45° field of view, image size 2352x1568, fundus photo — 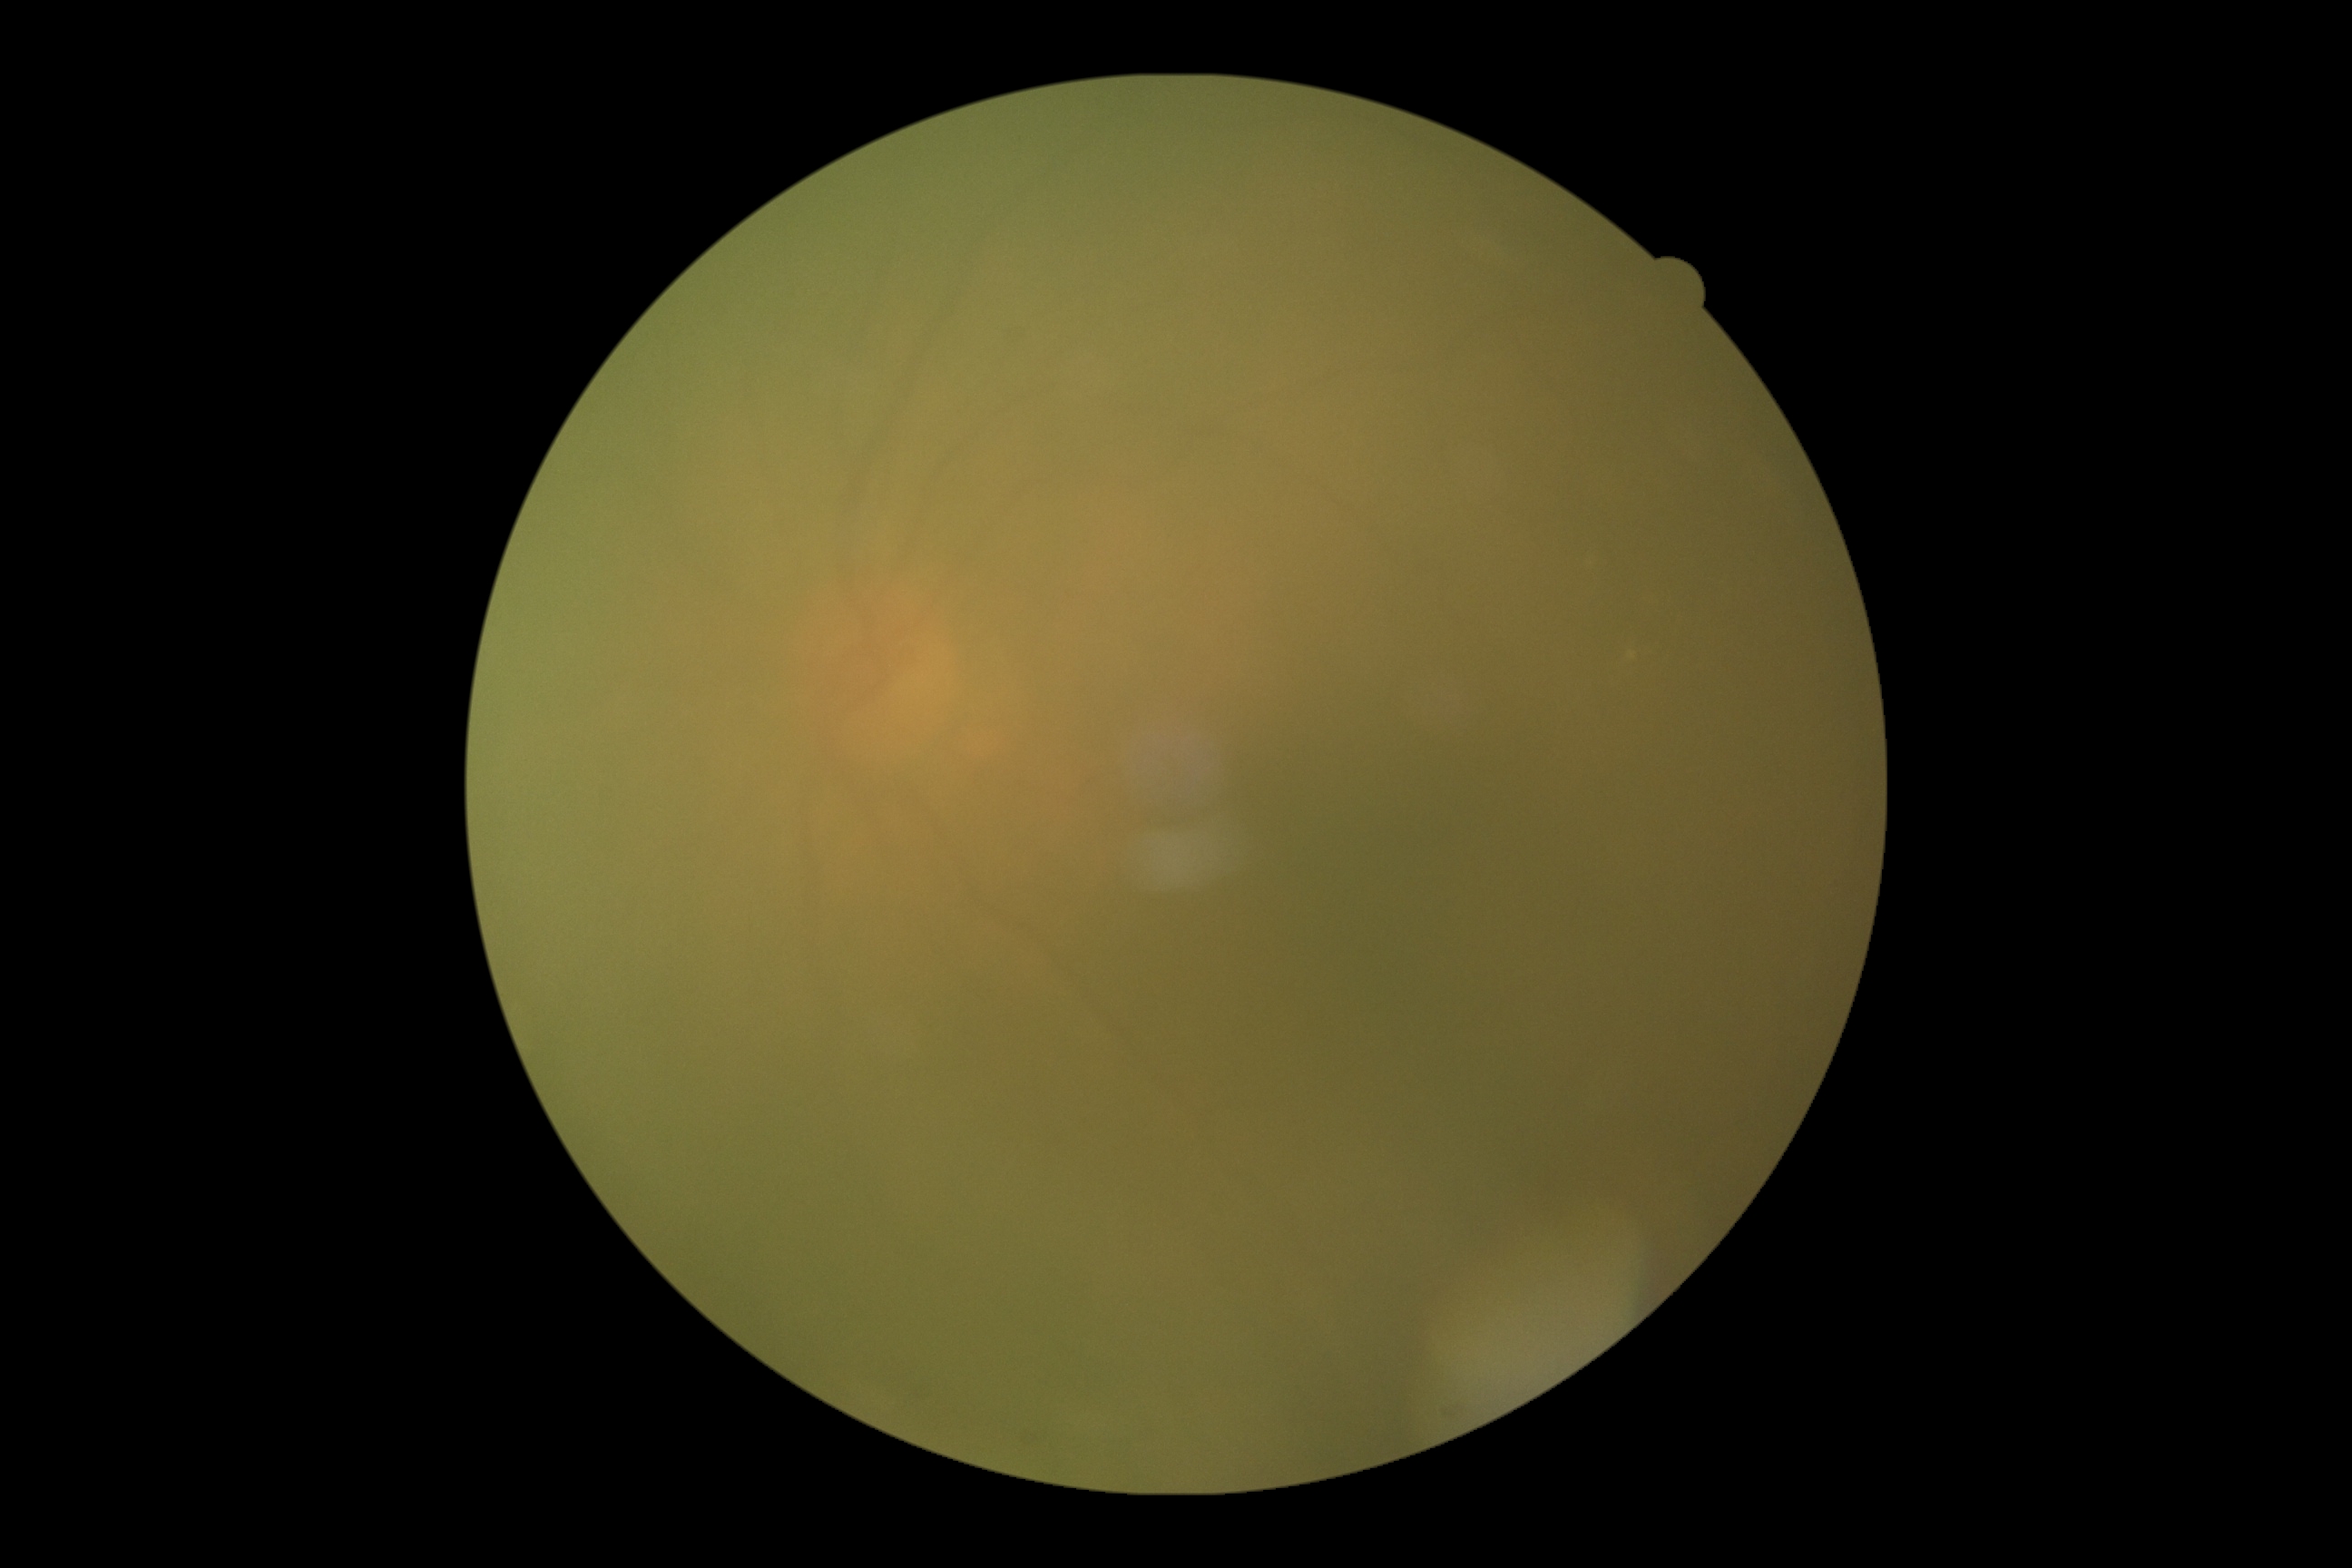

diabetic retinopathy grade = ungradable; image quality = too poor for DR grading.